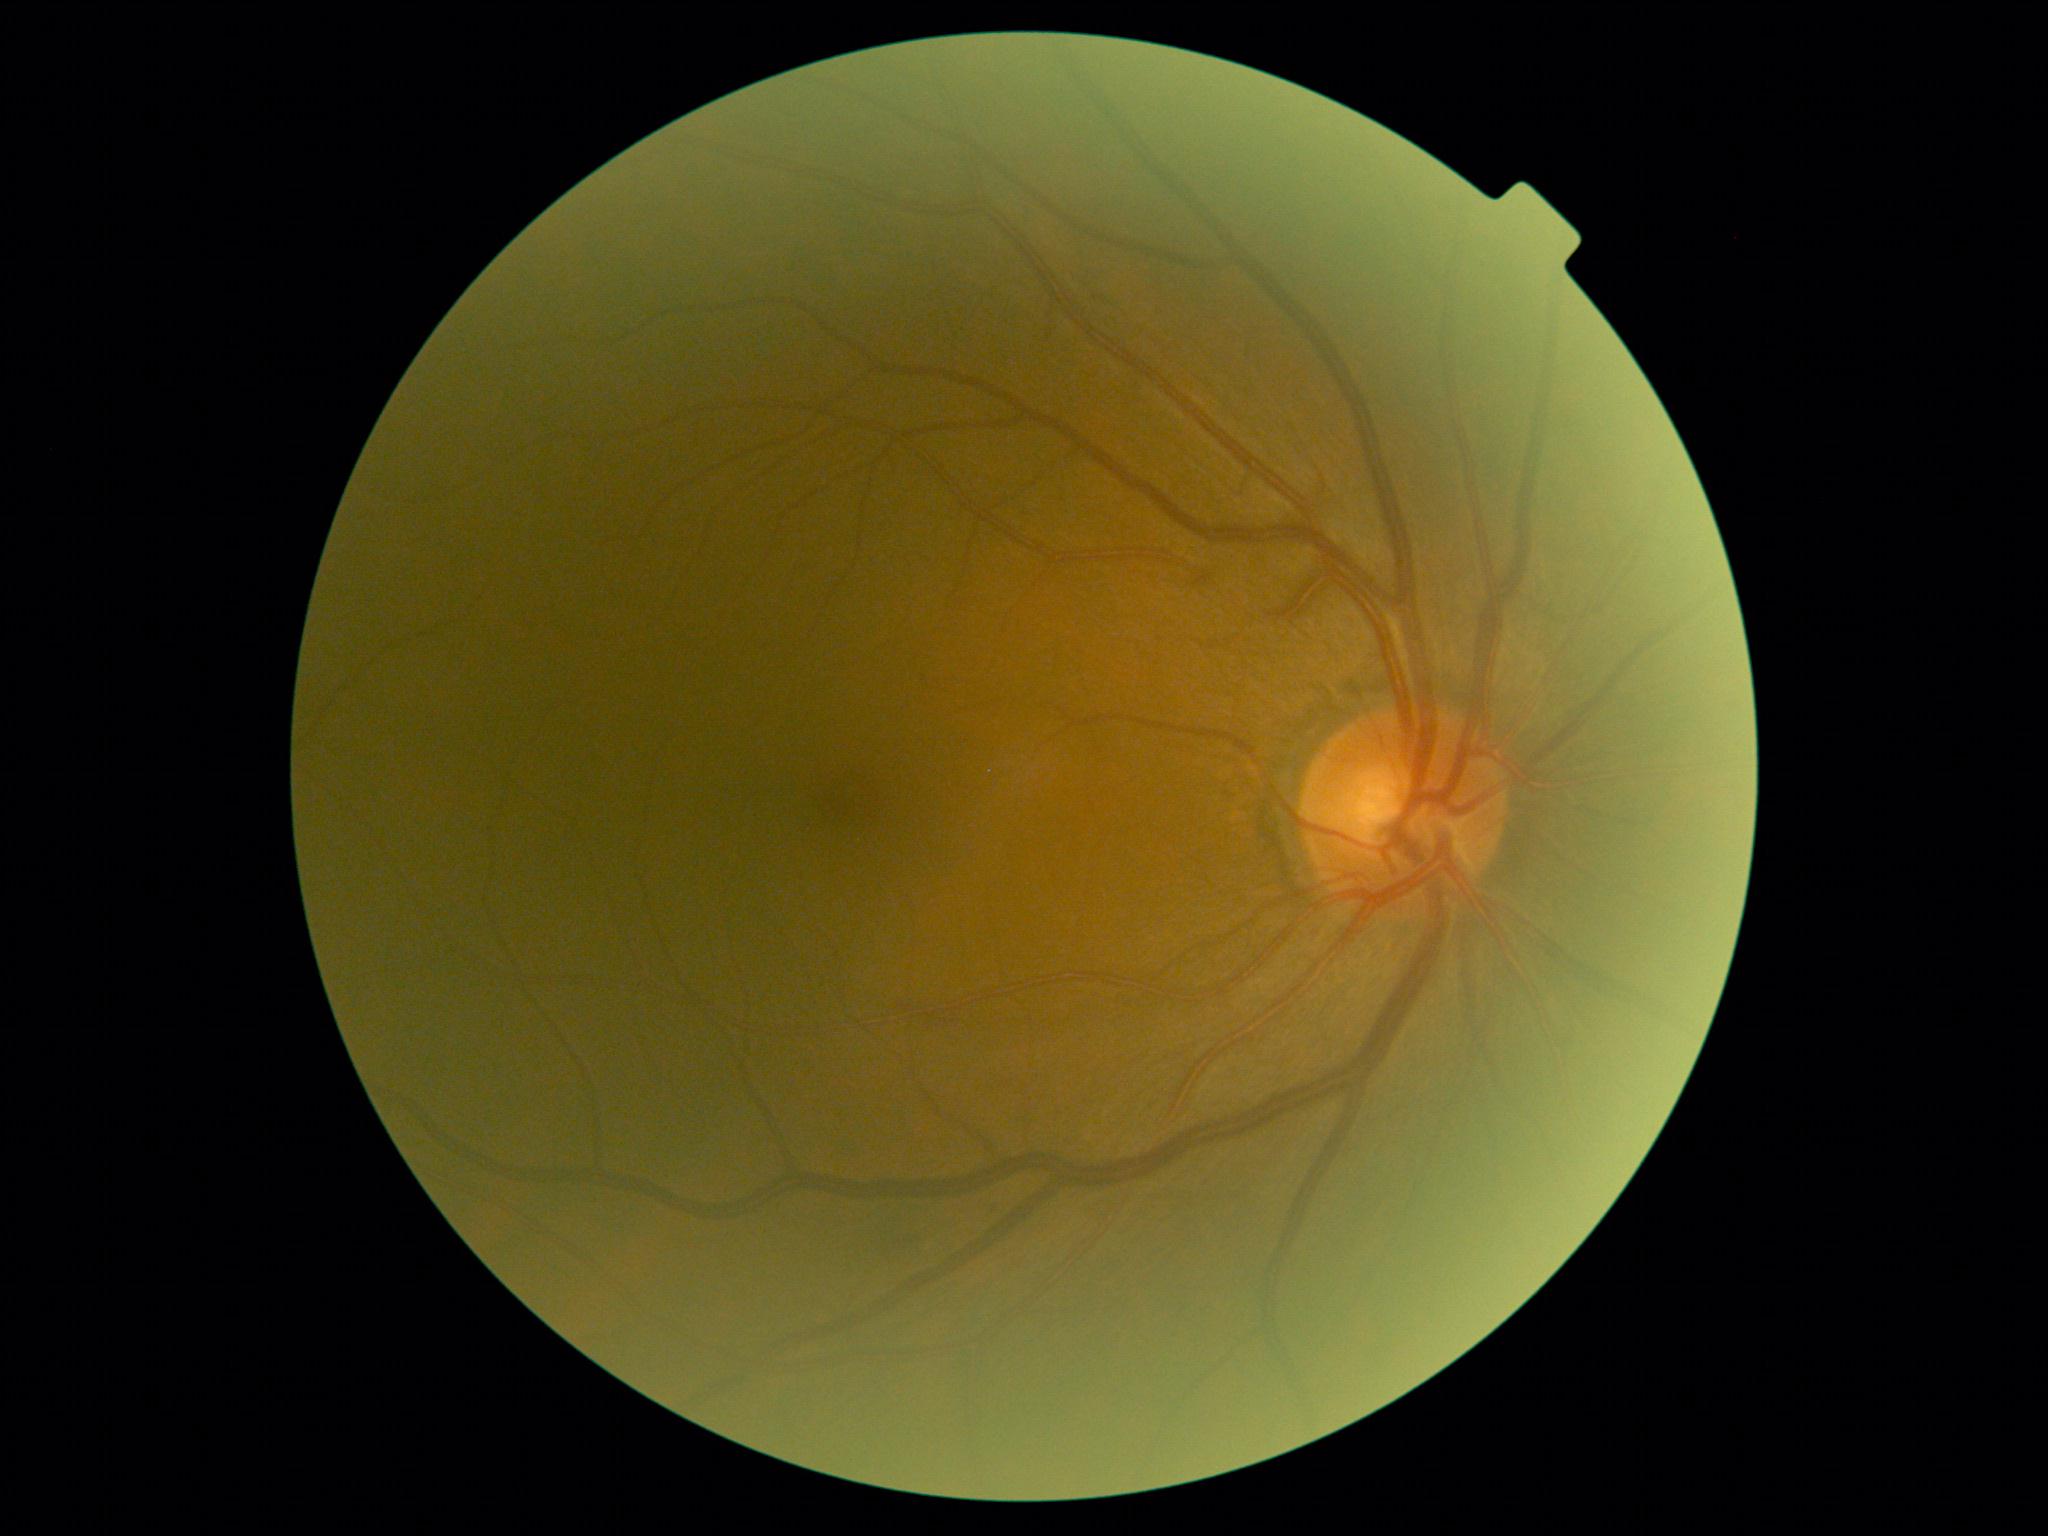

DR stage@mild NPDR (grade 1) — presence of microaneurysms only.